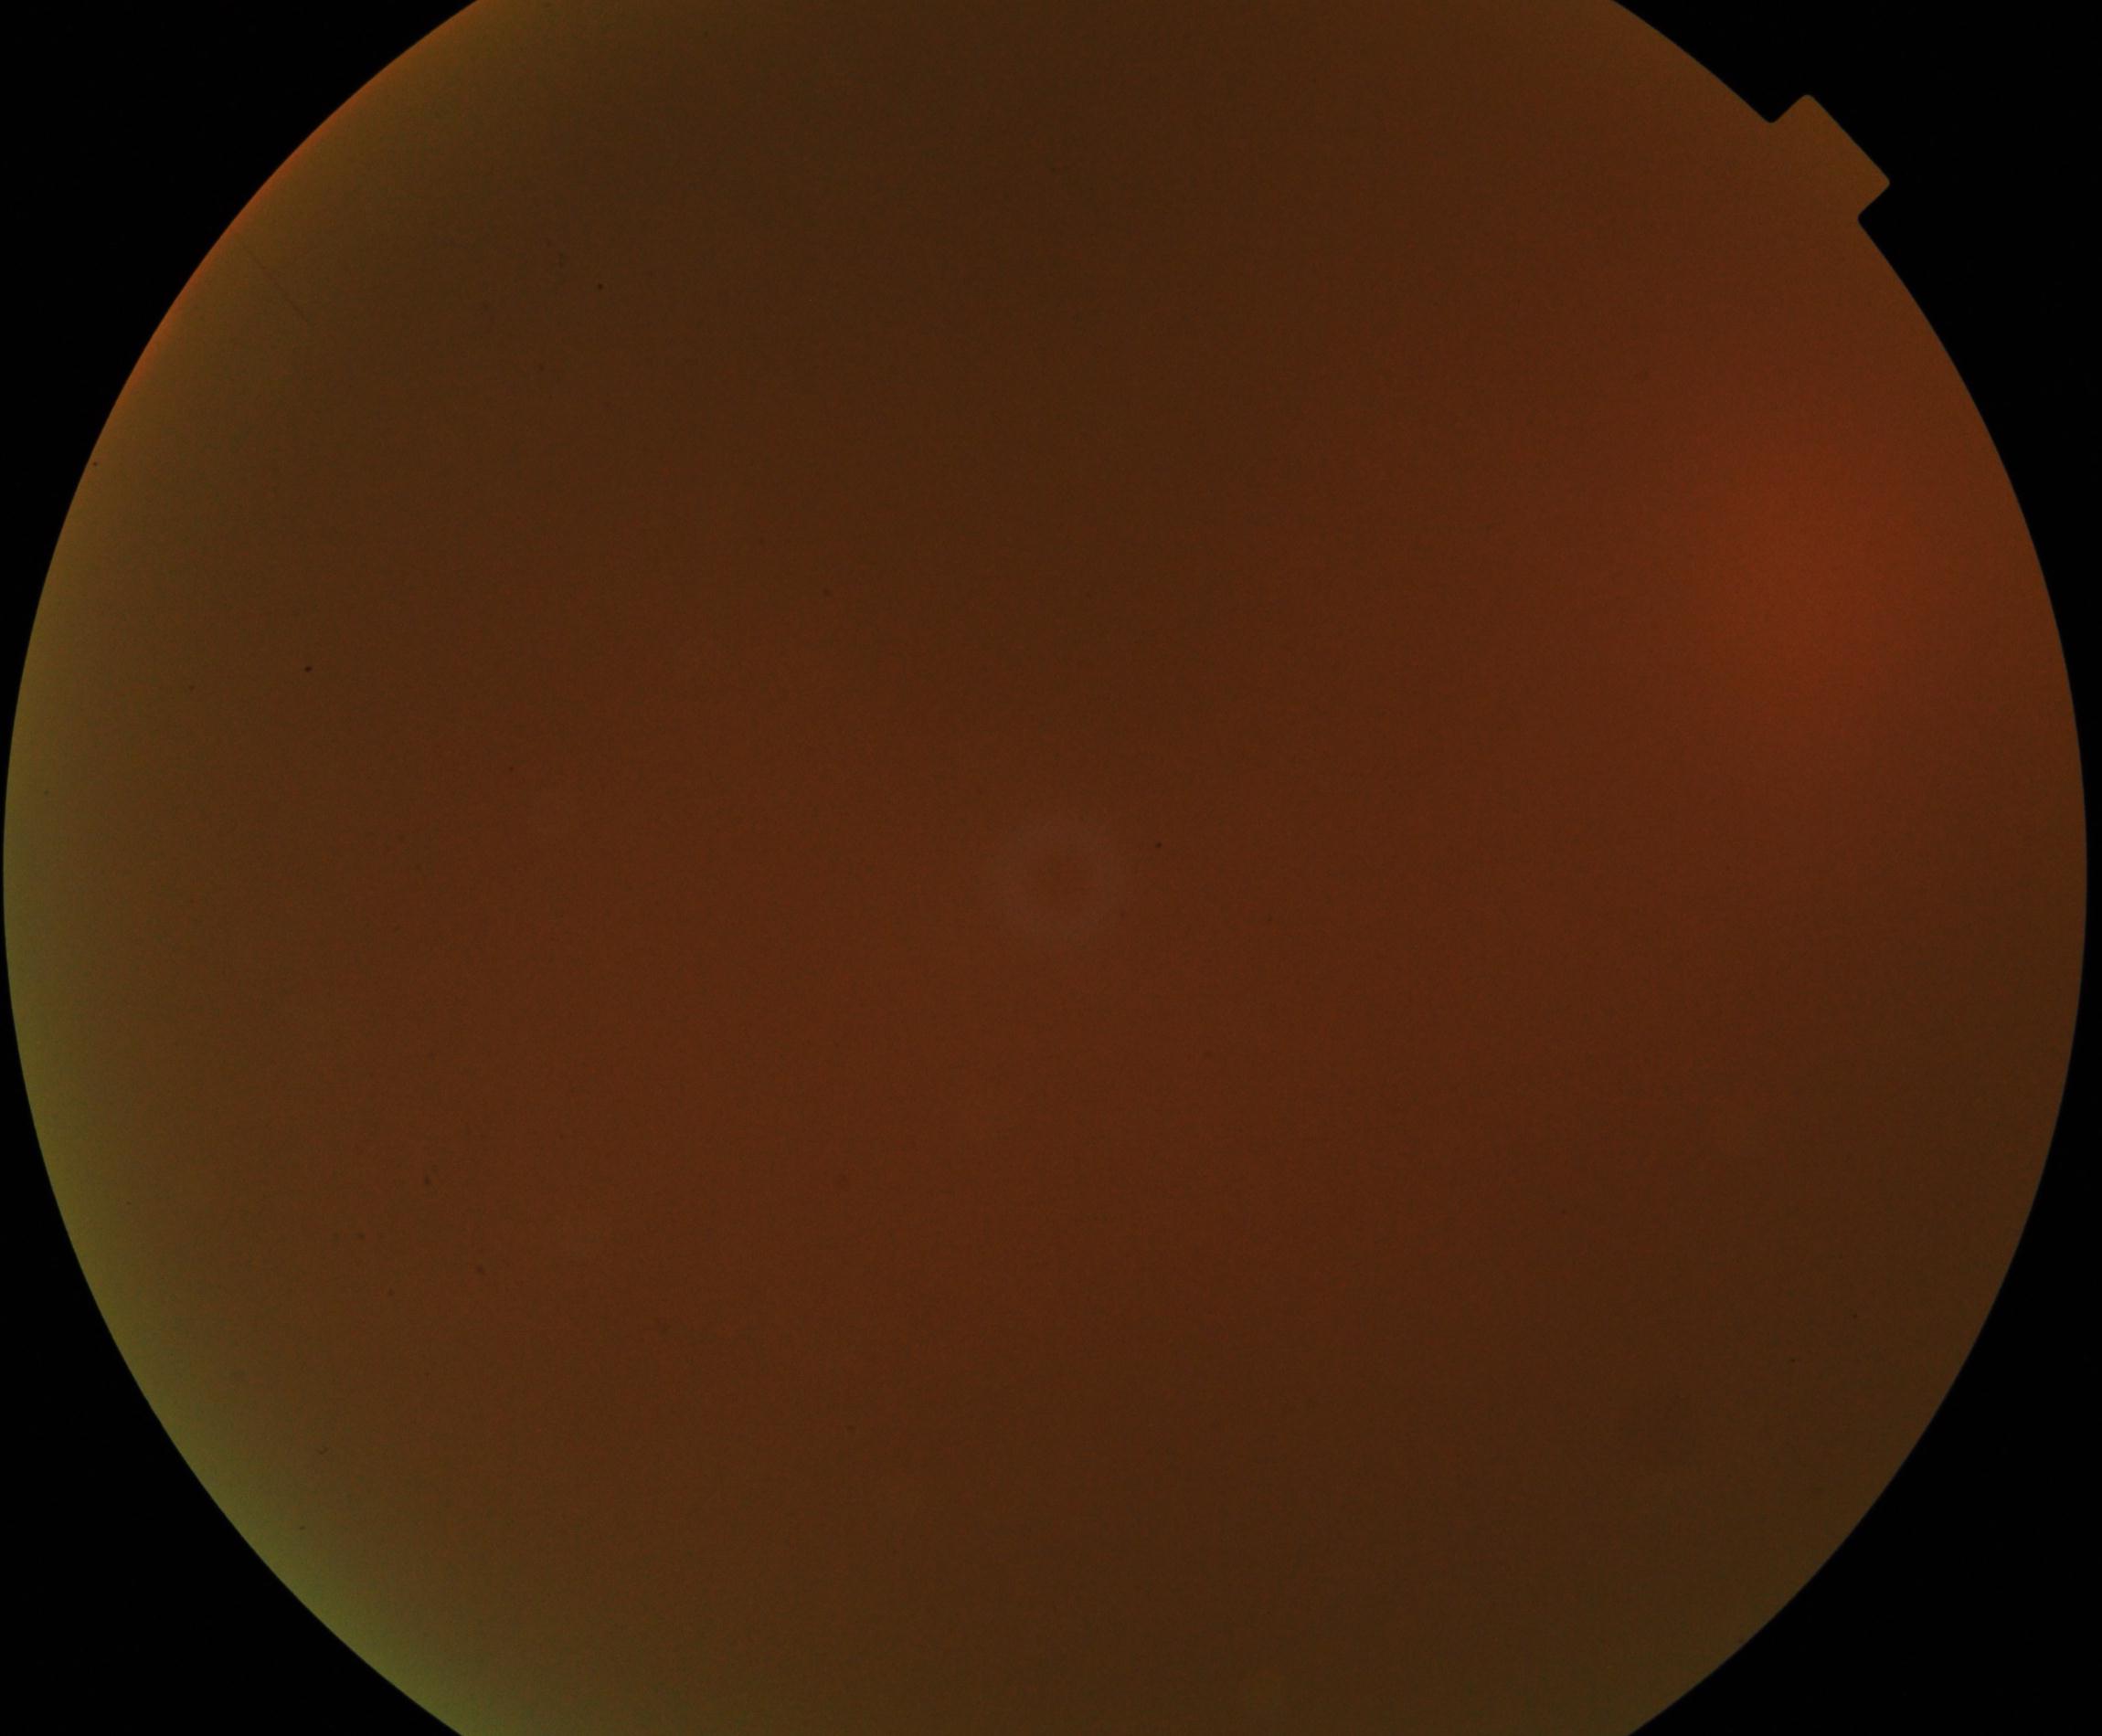 Blurred fundus image with substantial obscuration of retinal landmarks. Proliferative diabetic retinopathy not identified in the visible portion.